2352 by 1568 pixels · 45° FOV:
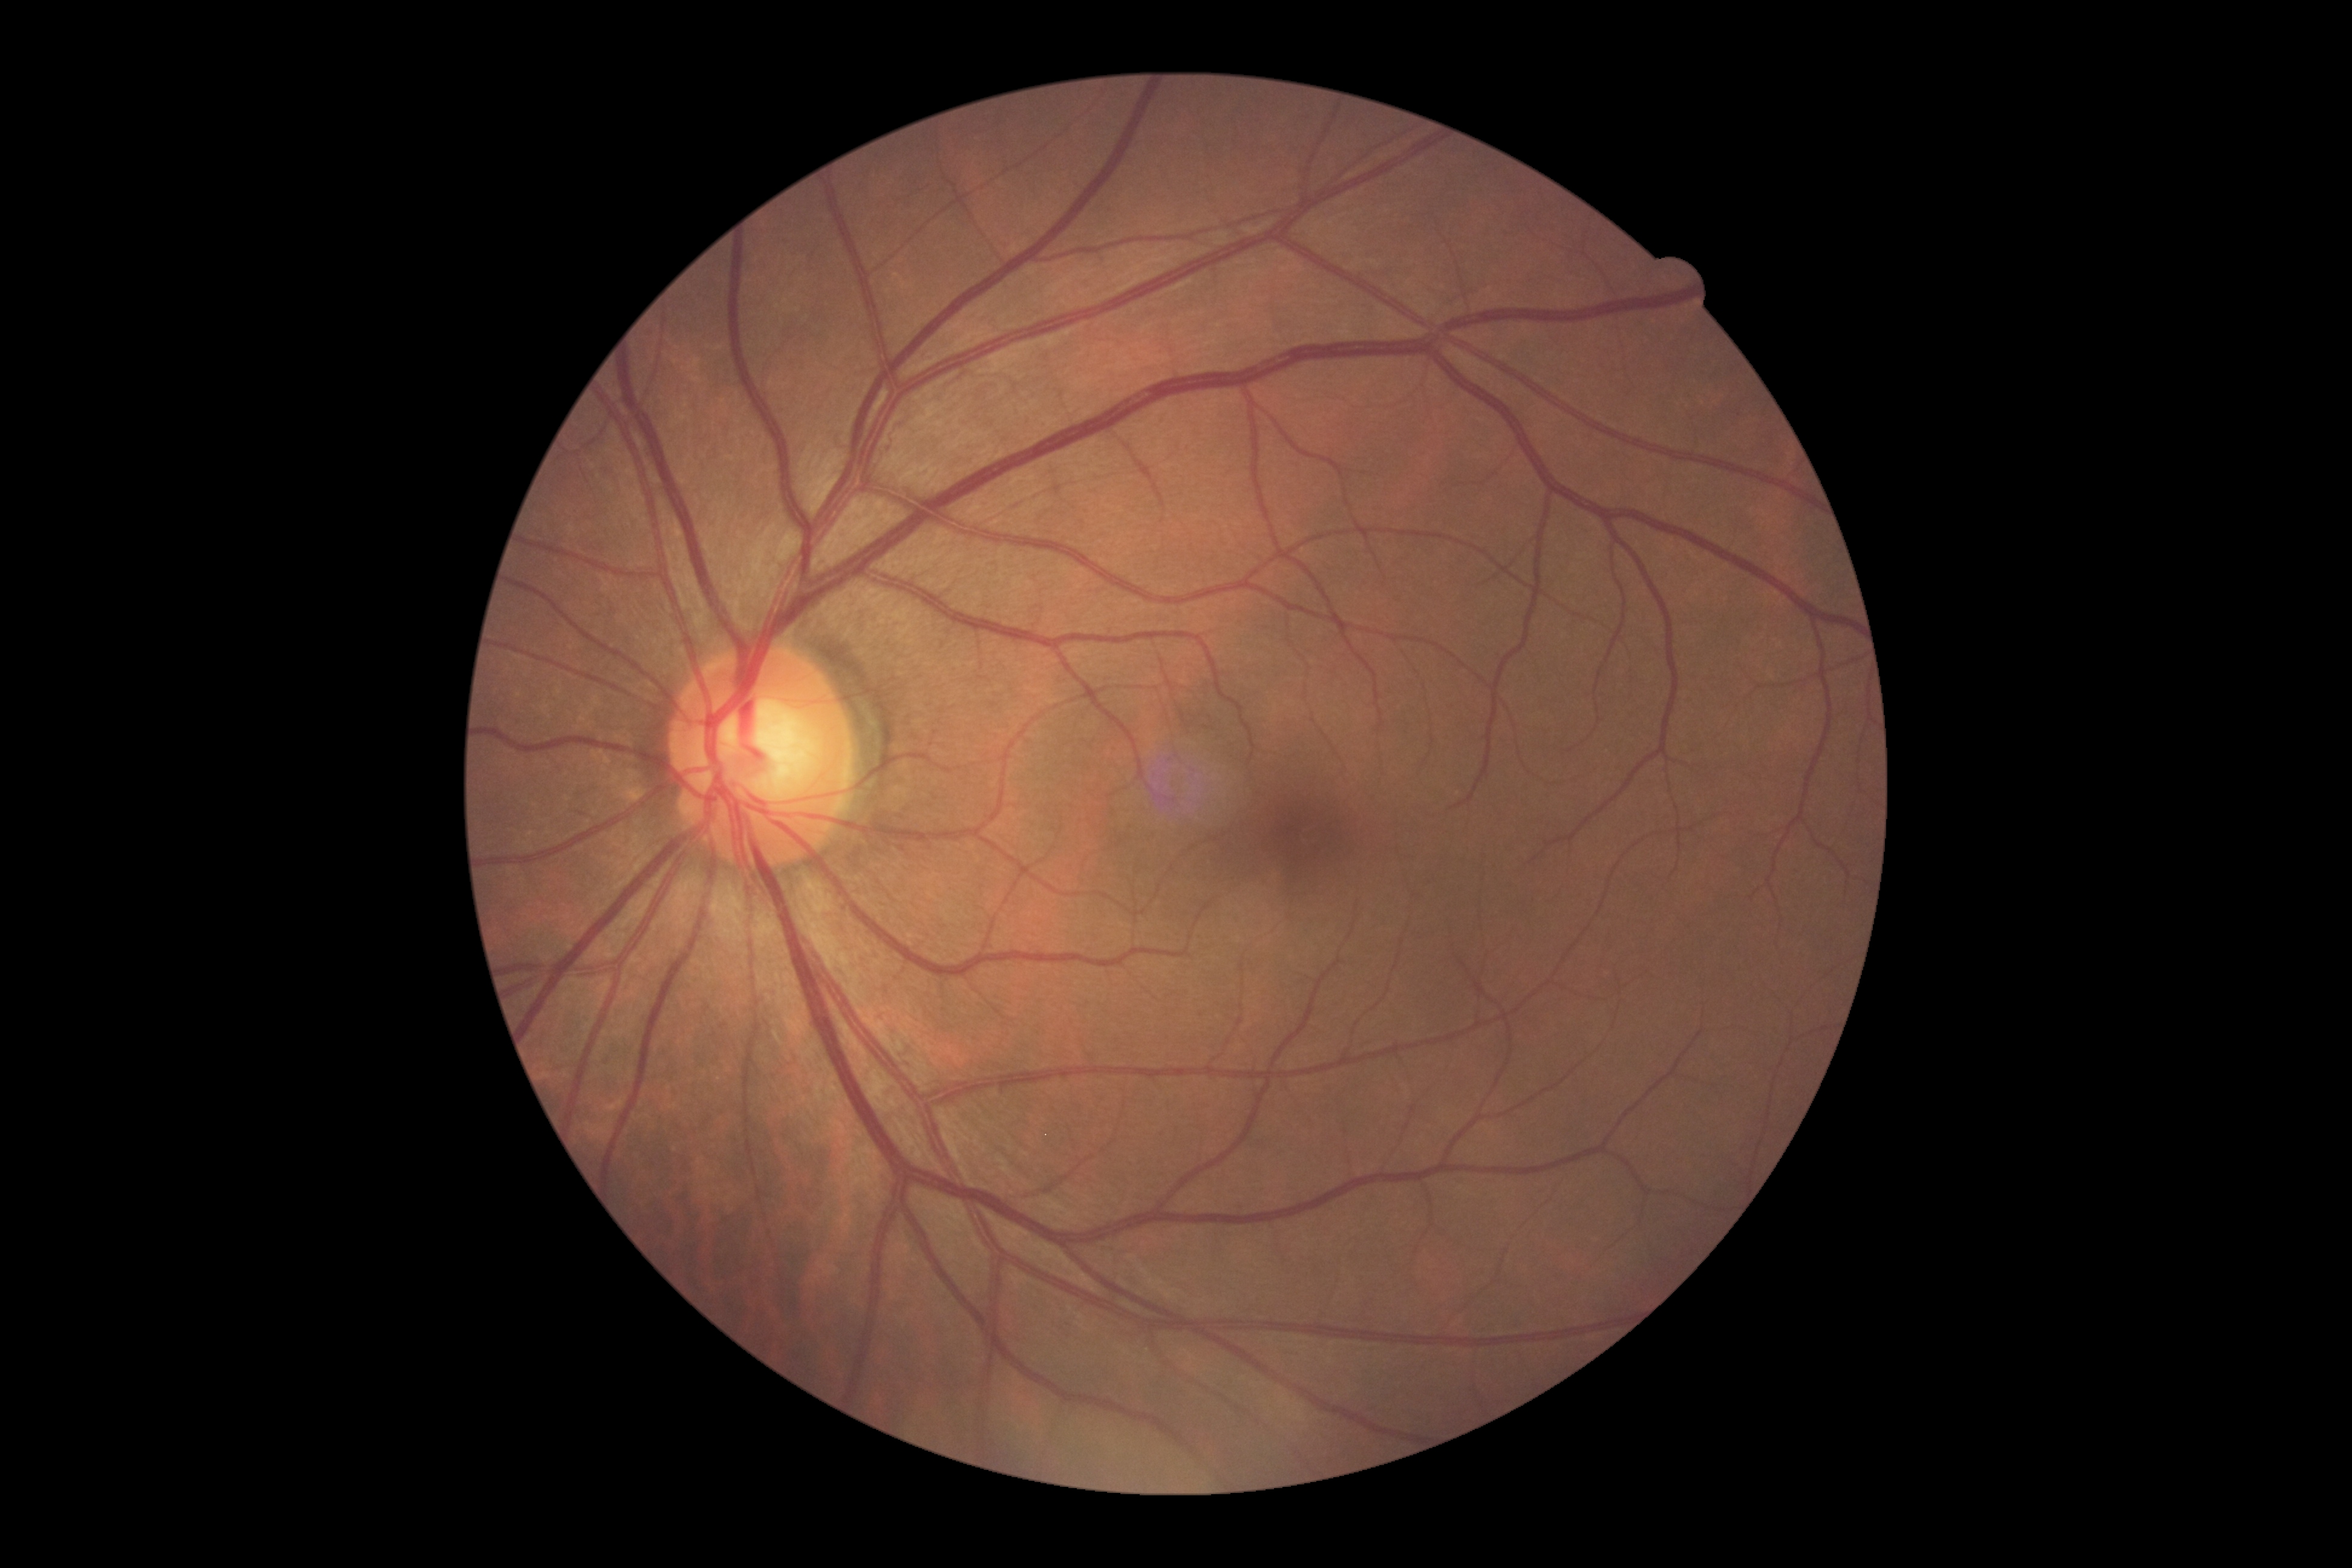

Diabetic retinopathy (DR): grade 0 (no apparent retinopathy).